Fundus photo.
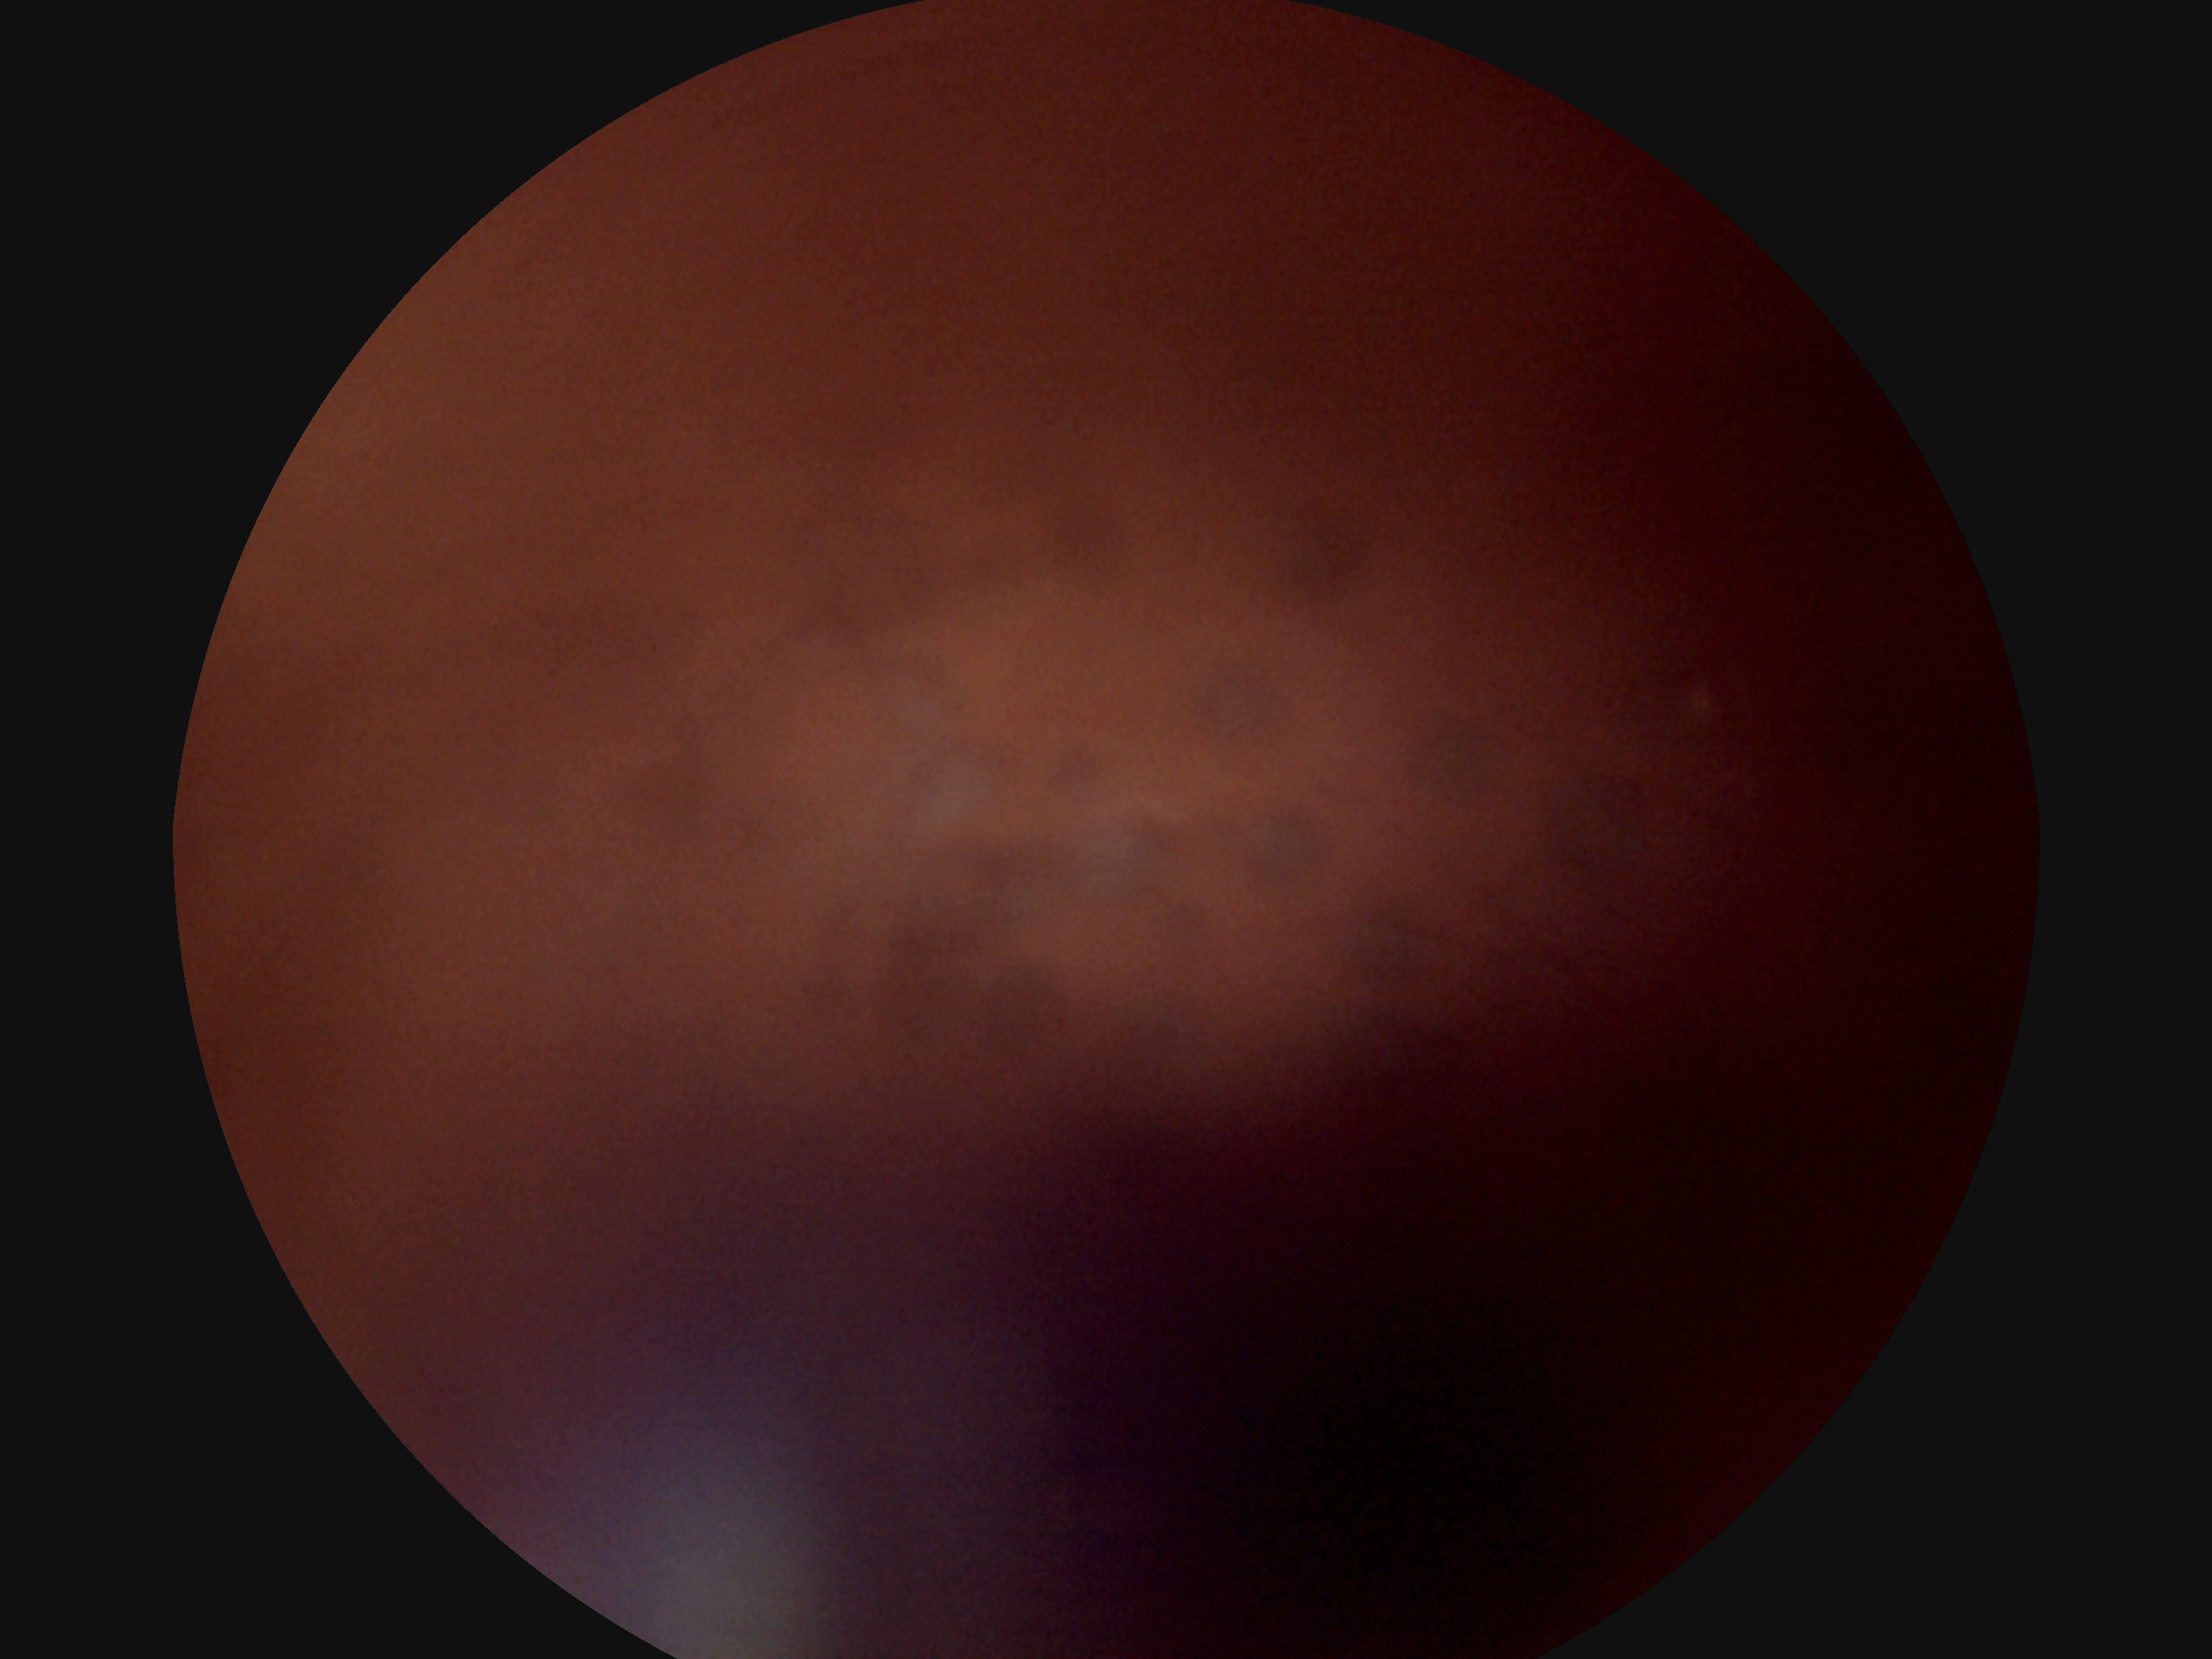
Diabetic retinopathy (DR): ungradable.